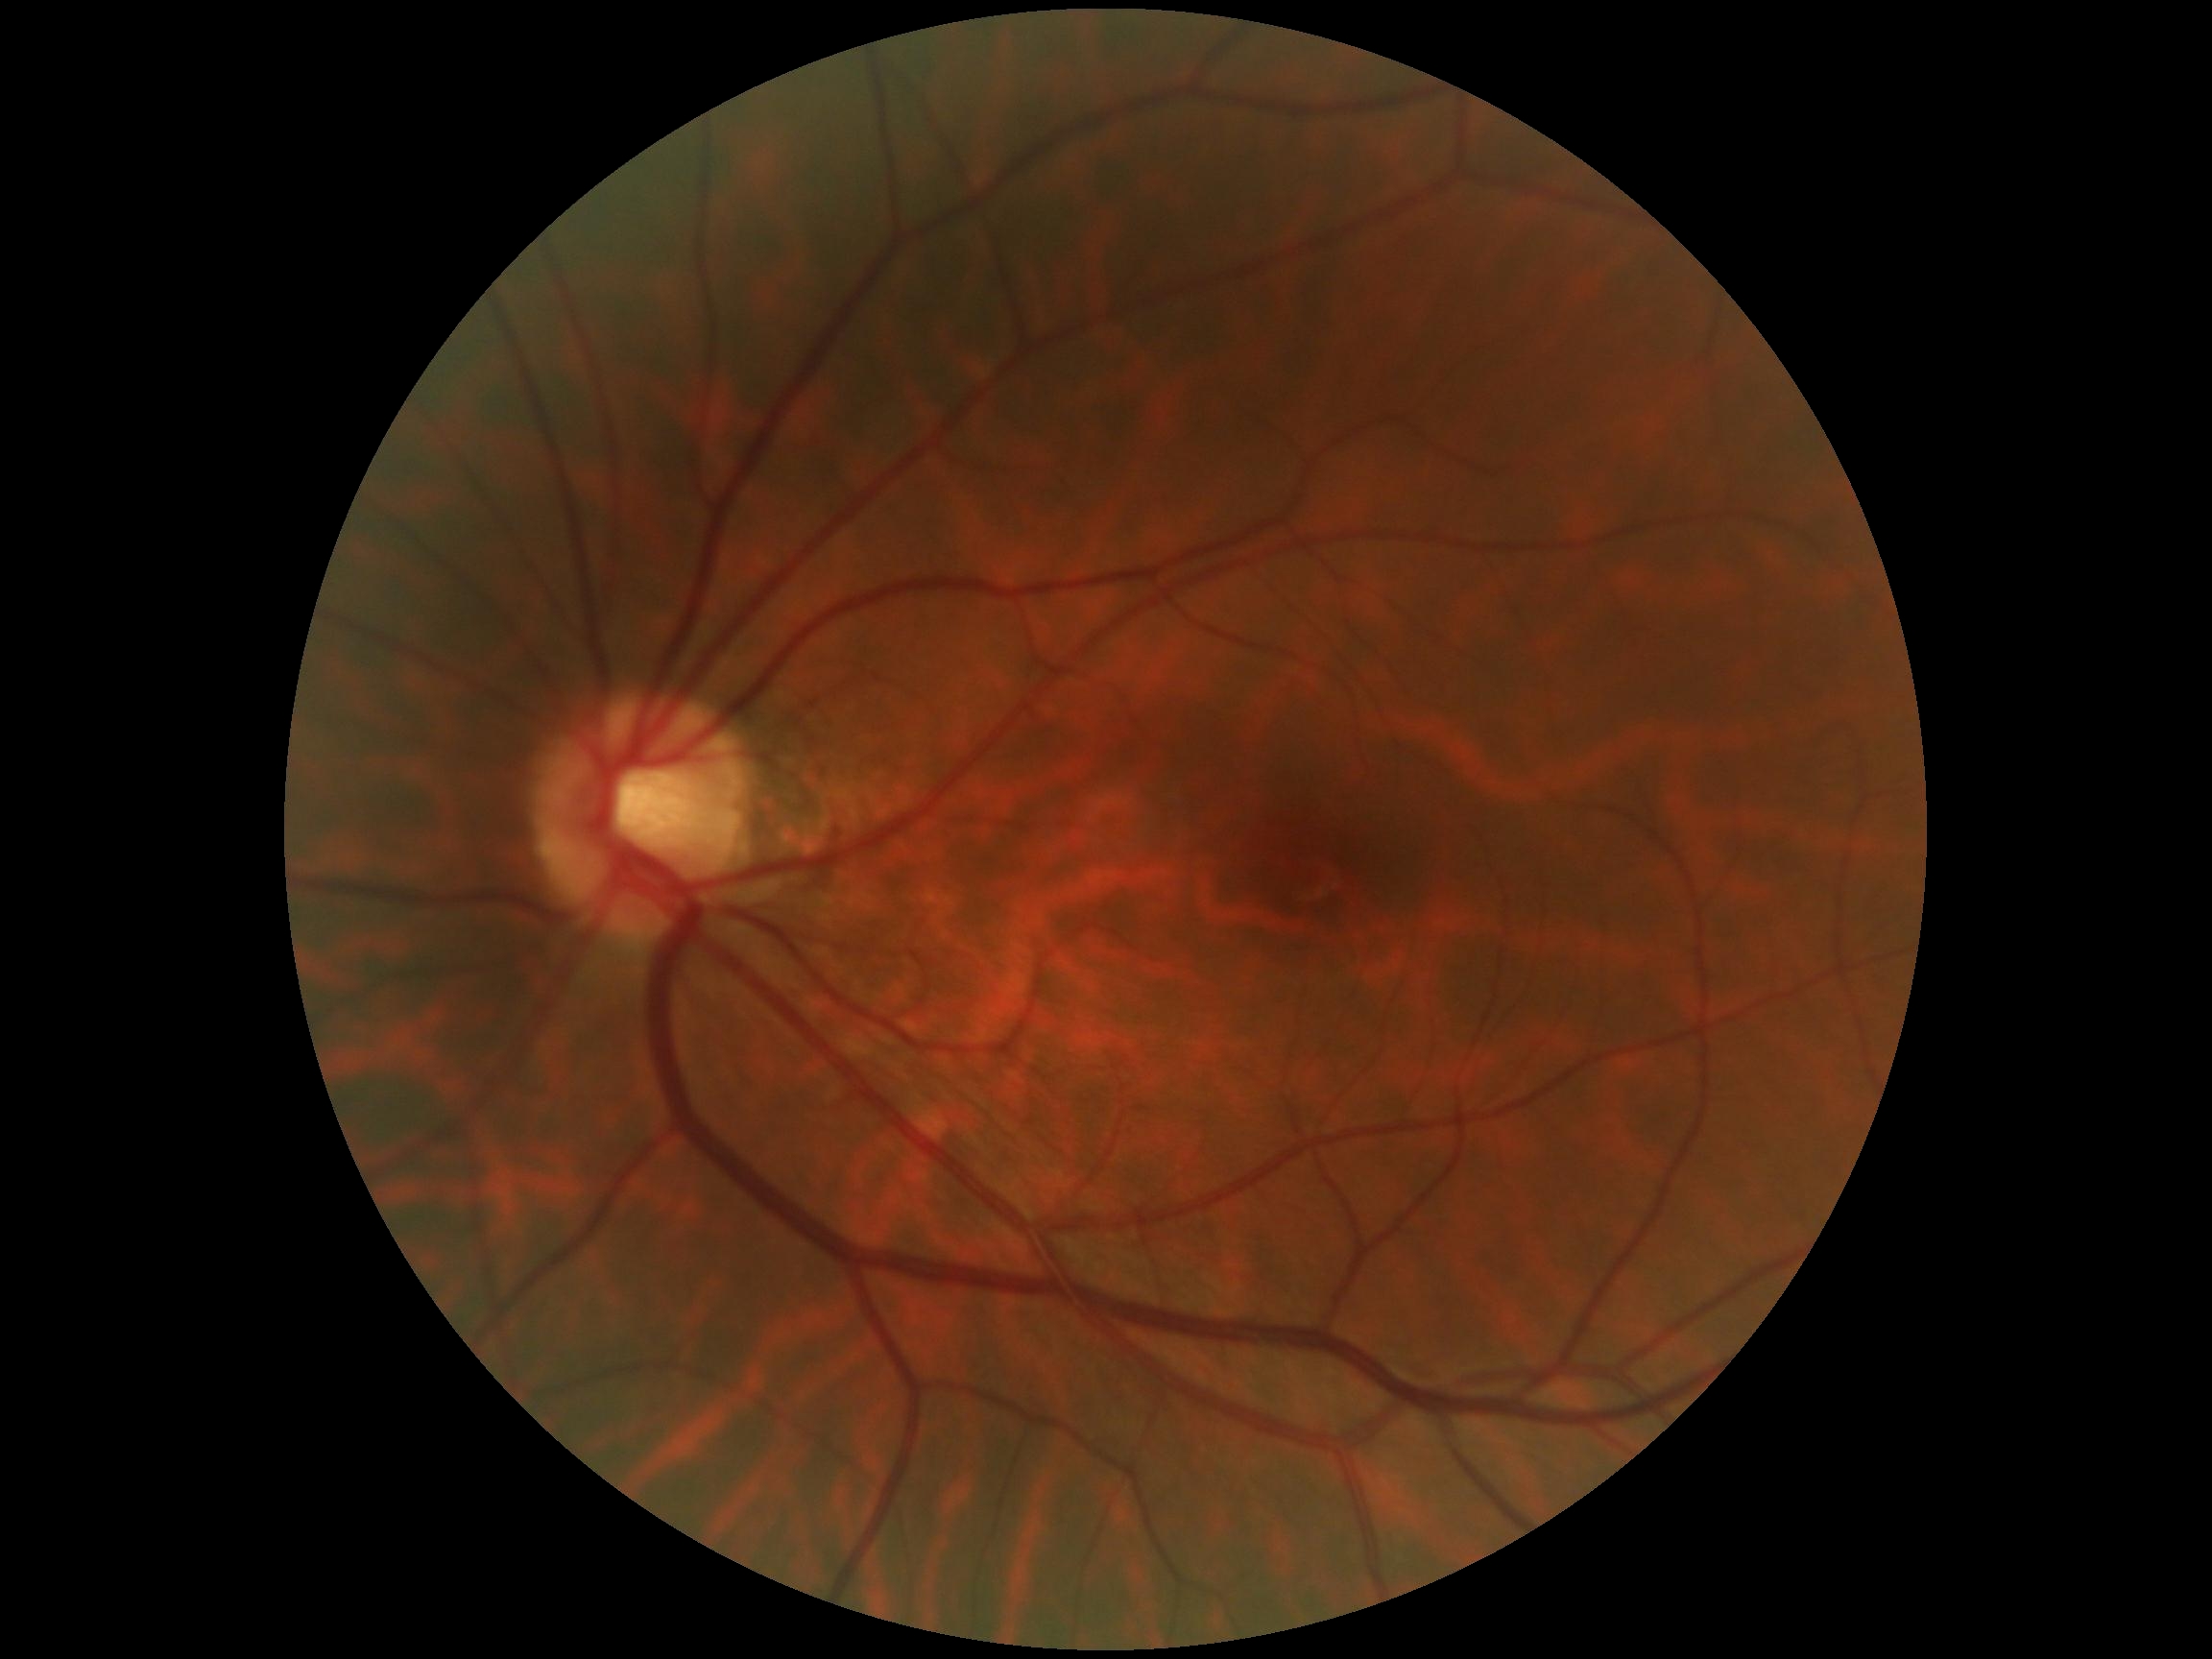

DR severity = grade 0 (no apparent retinopathy)